60° FOV · portable fundus camera image:
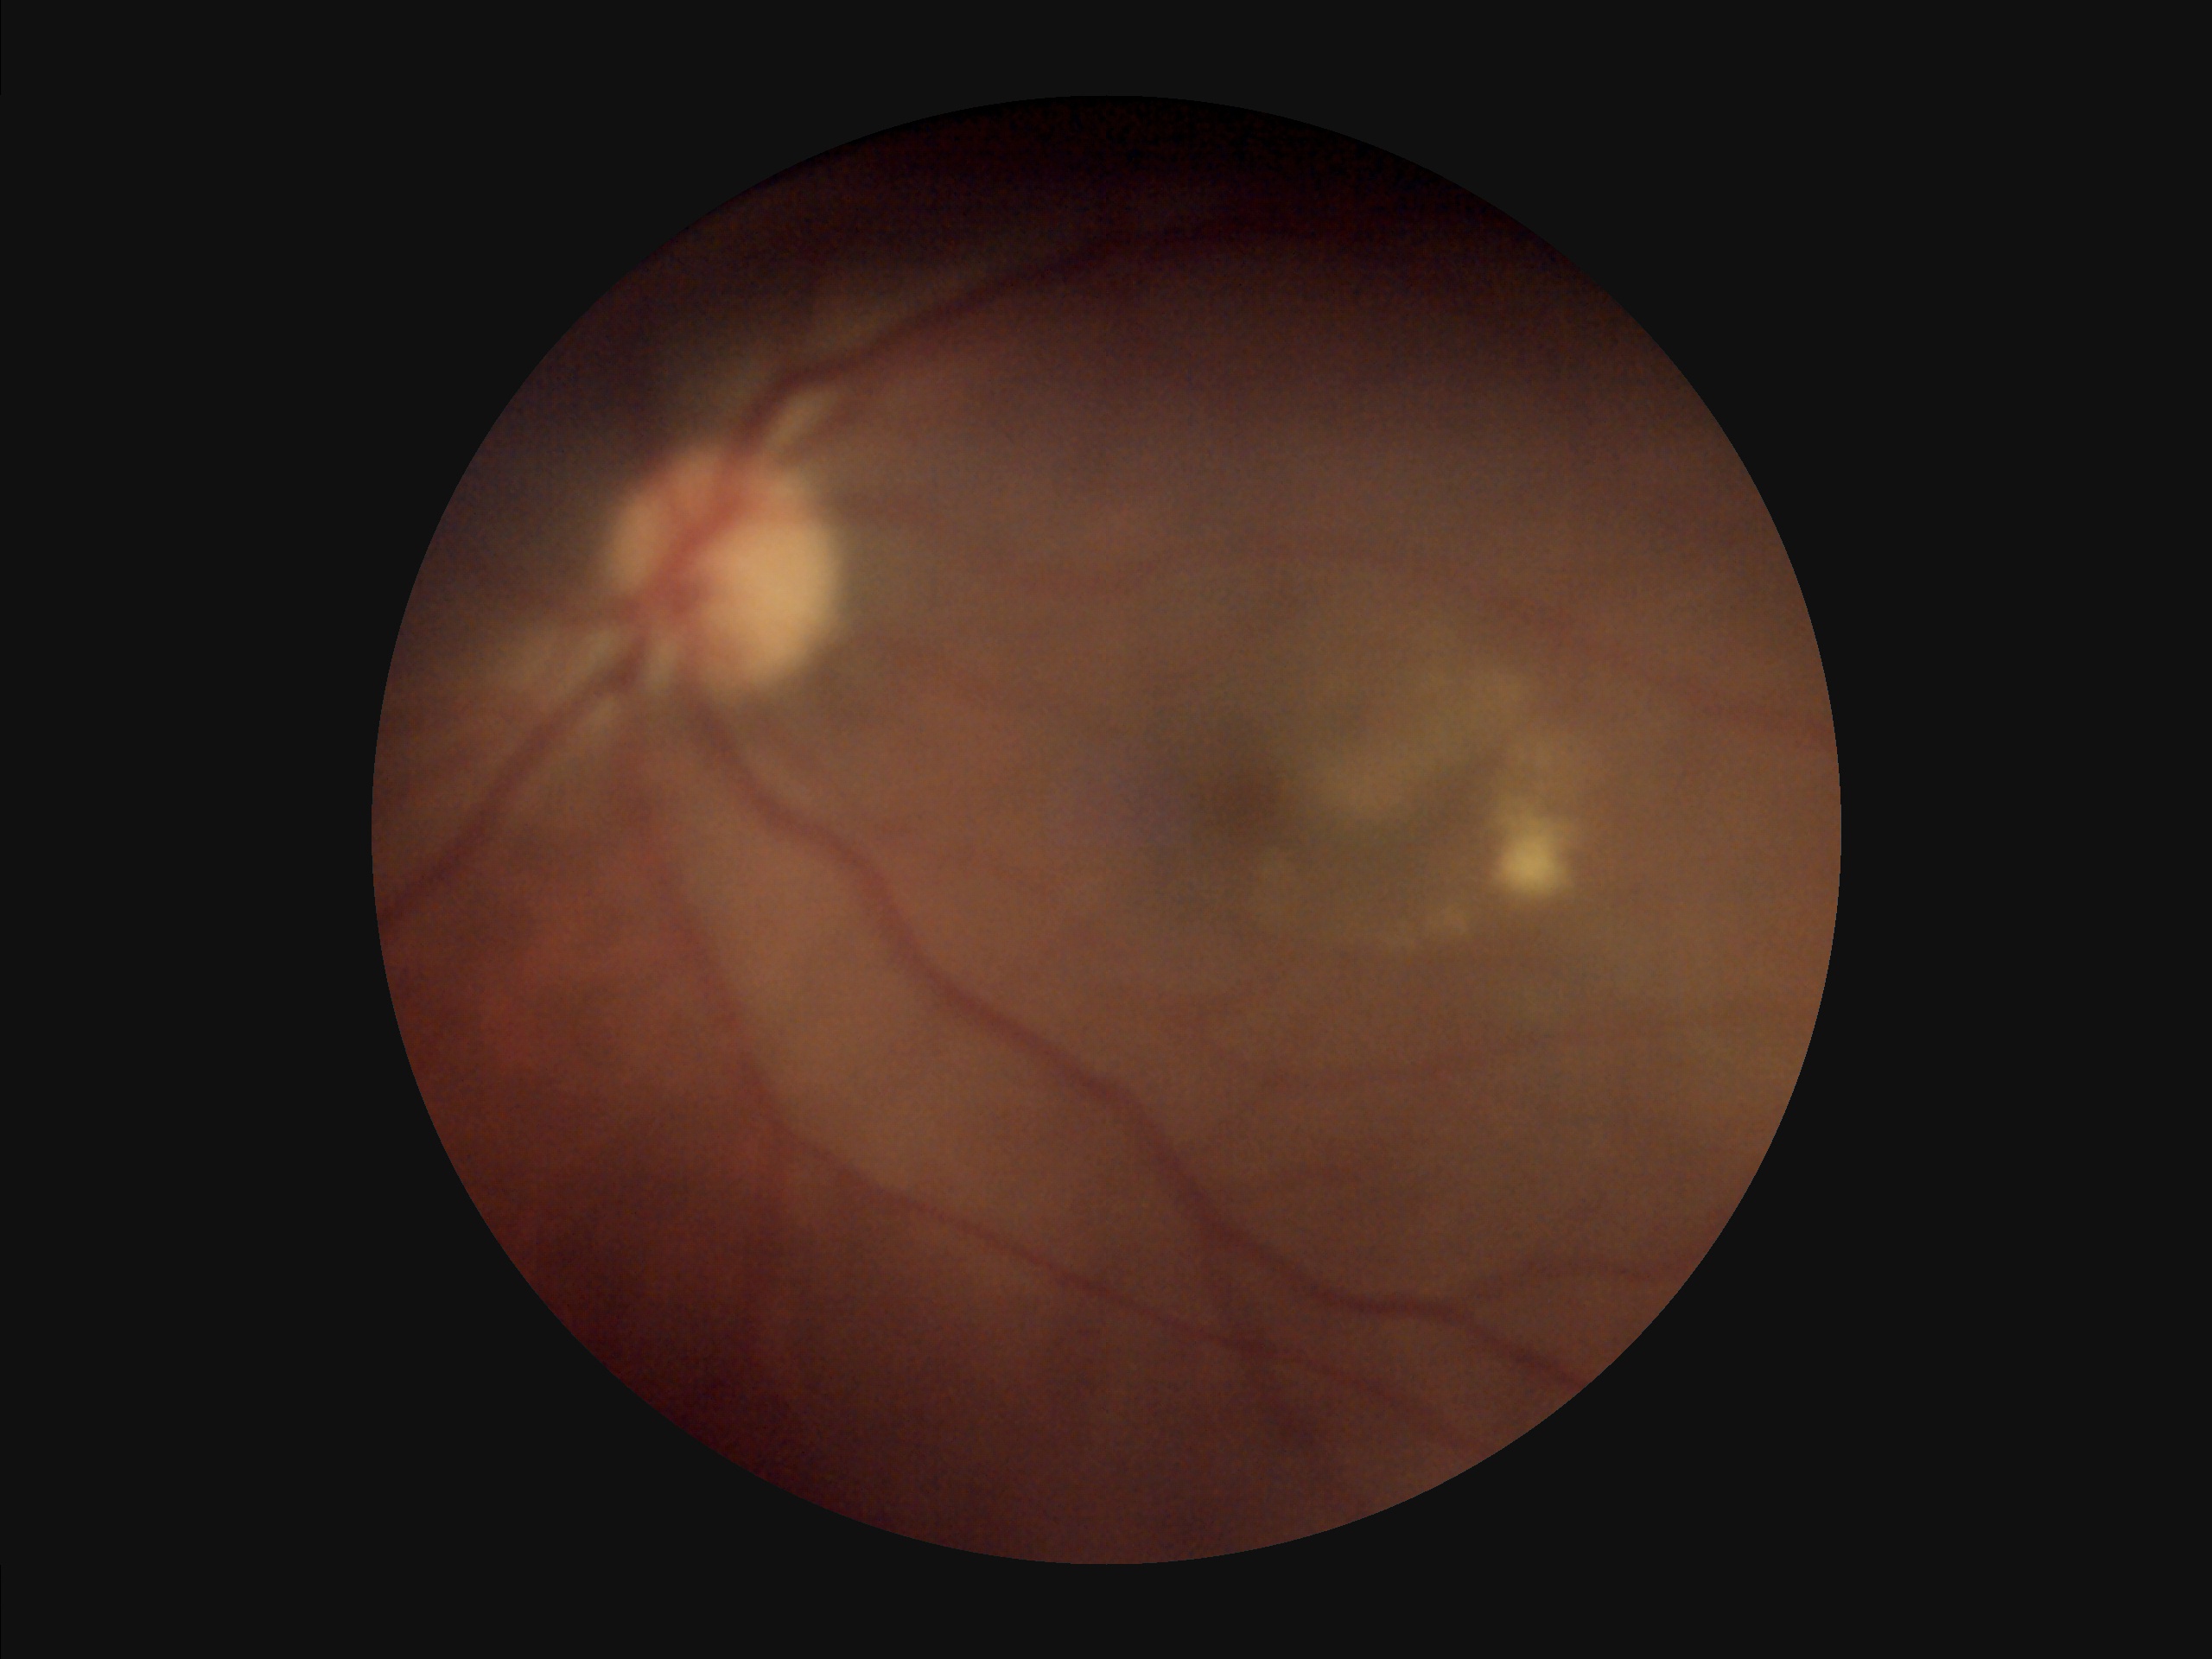

{
  "overall_quality": "suboptimal",
  "illumination": "uneven"
}